45-degree field of view — 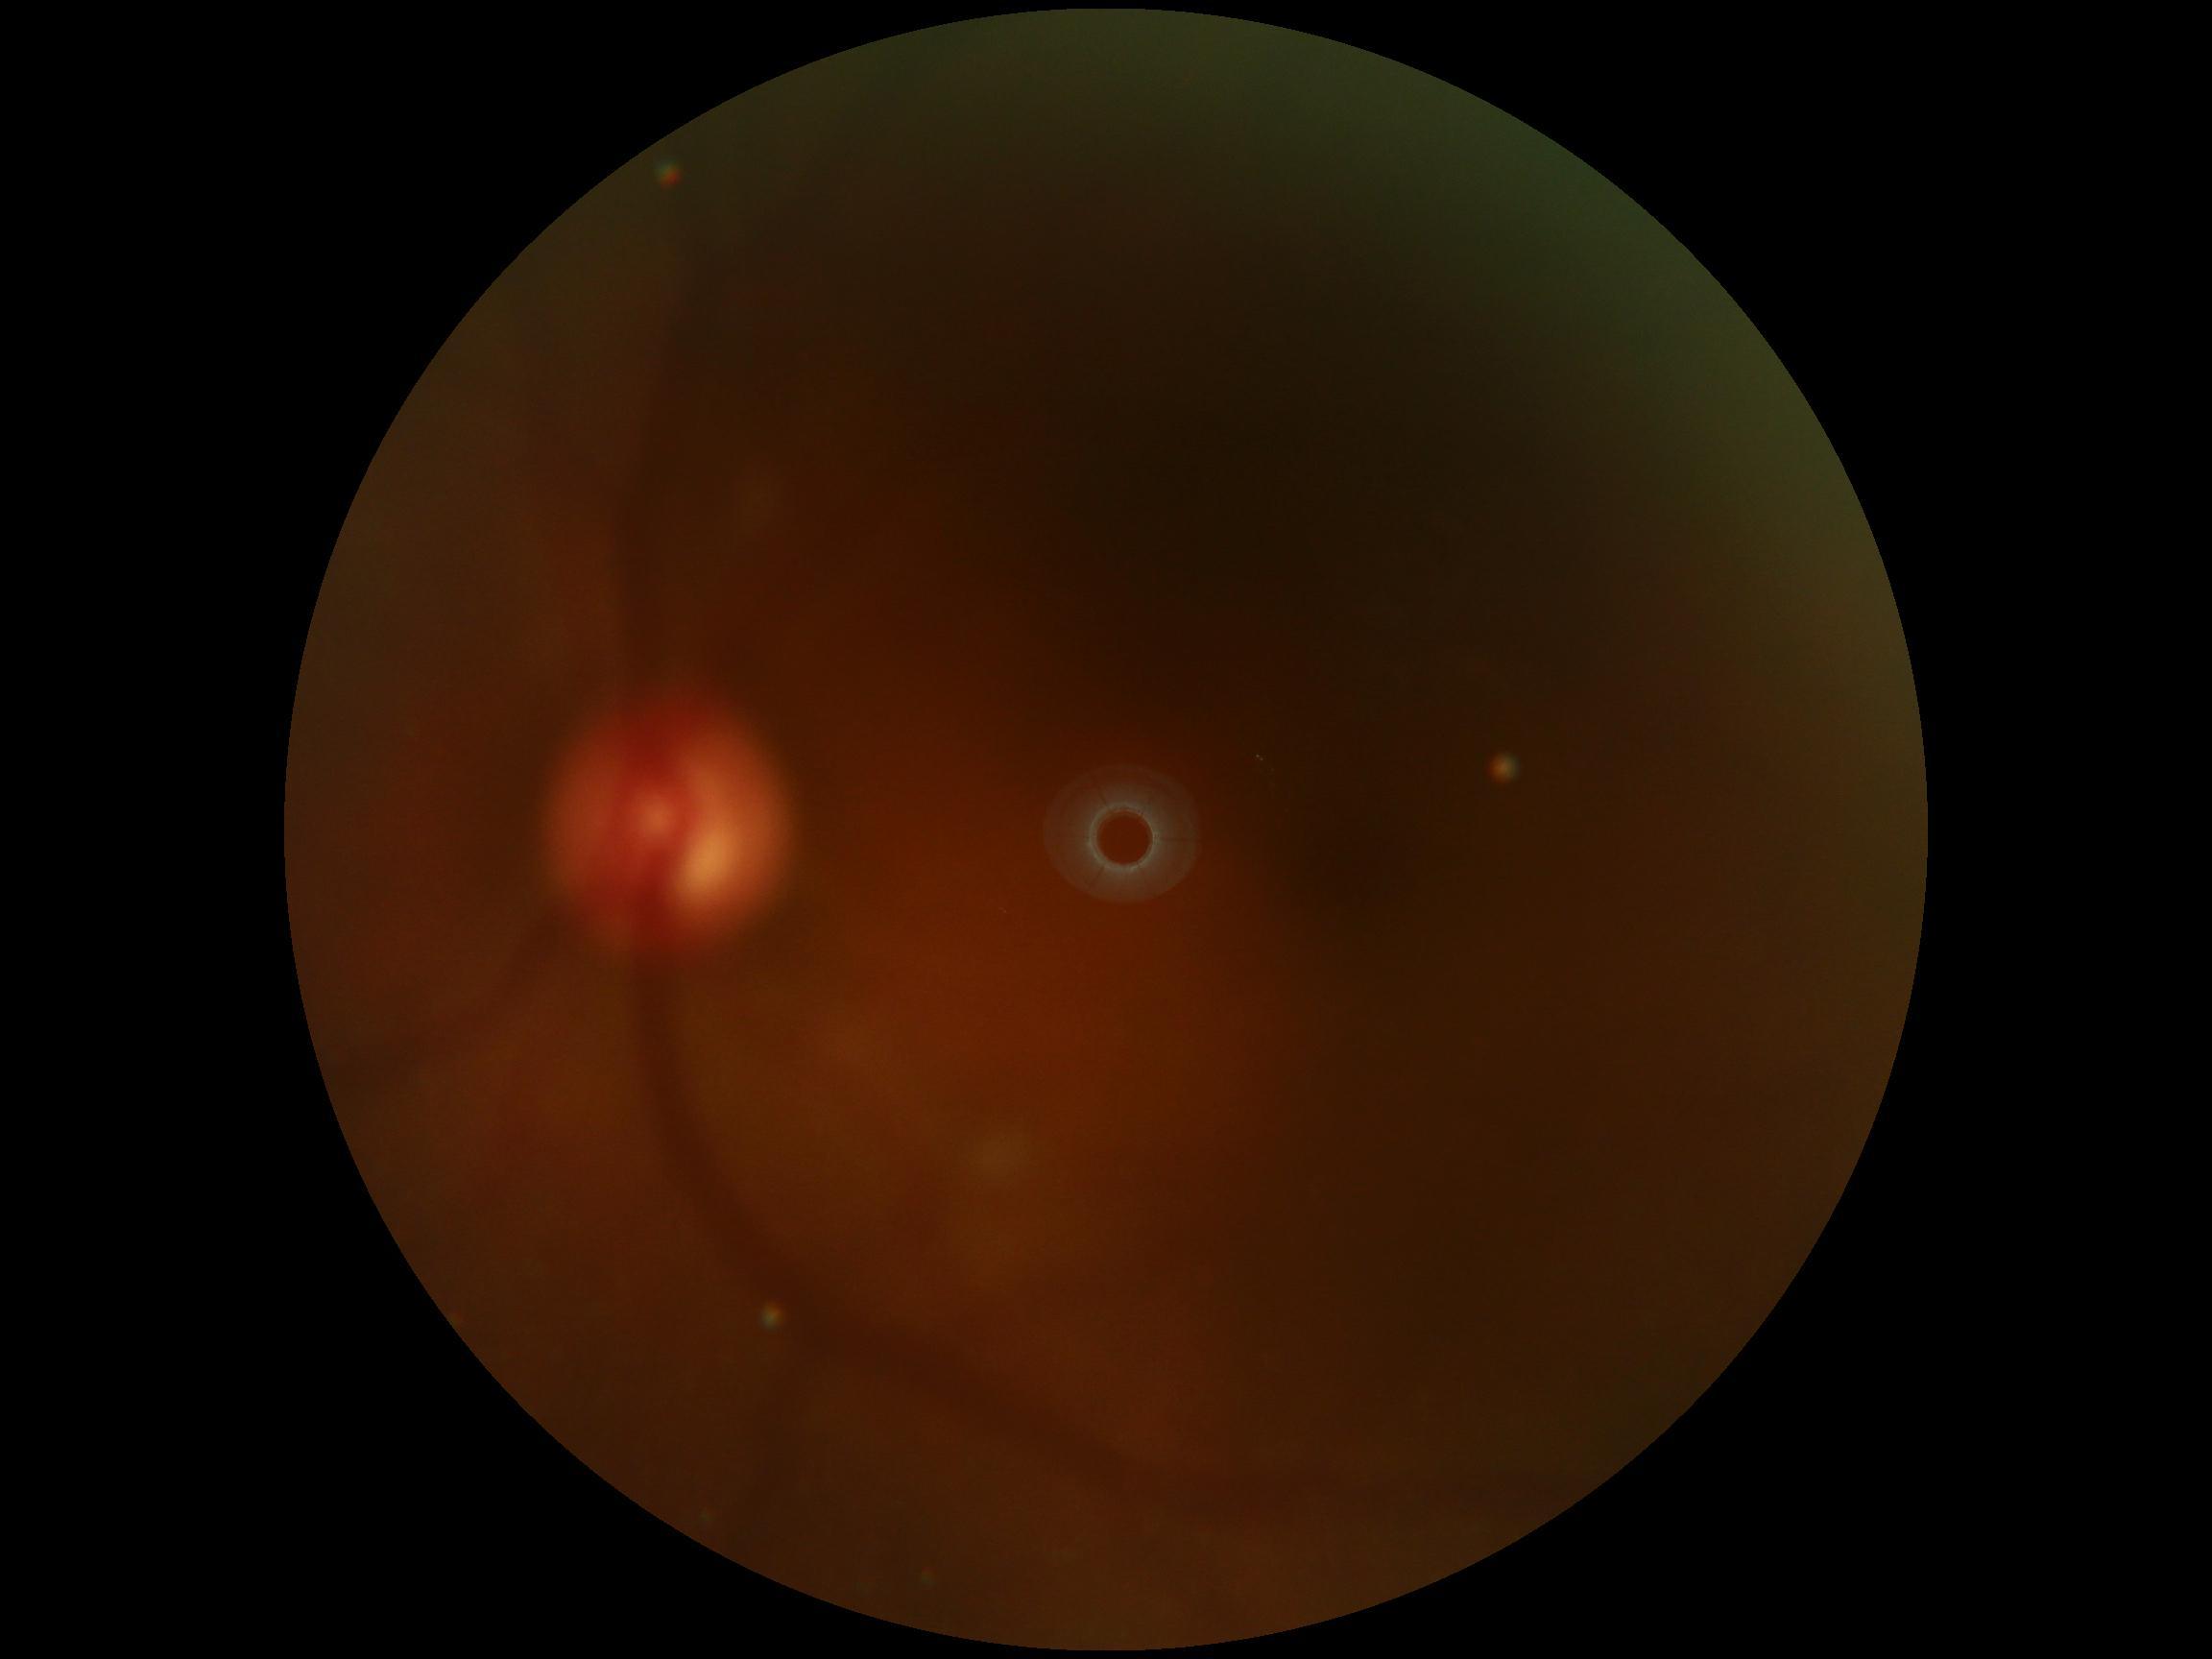 Quality too poor to assess for DR. DR stage is ungradable due to poor image quality.